Davis DR grading: 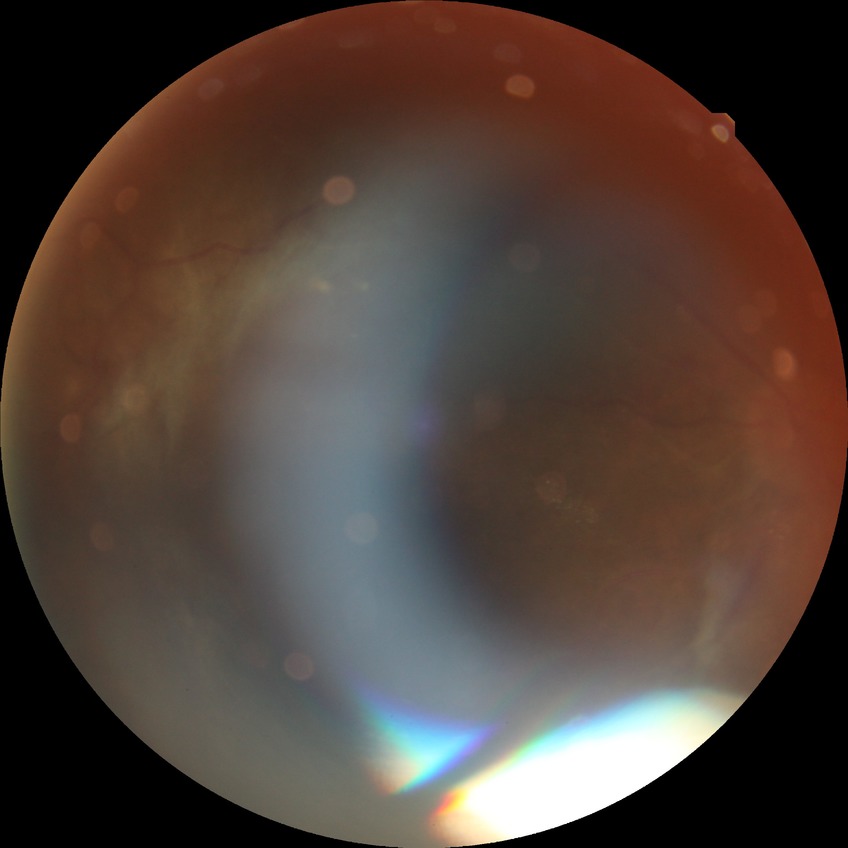
Retinopathy stage is proliferative diabetic retinopathy.